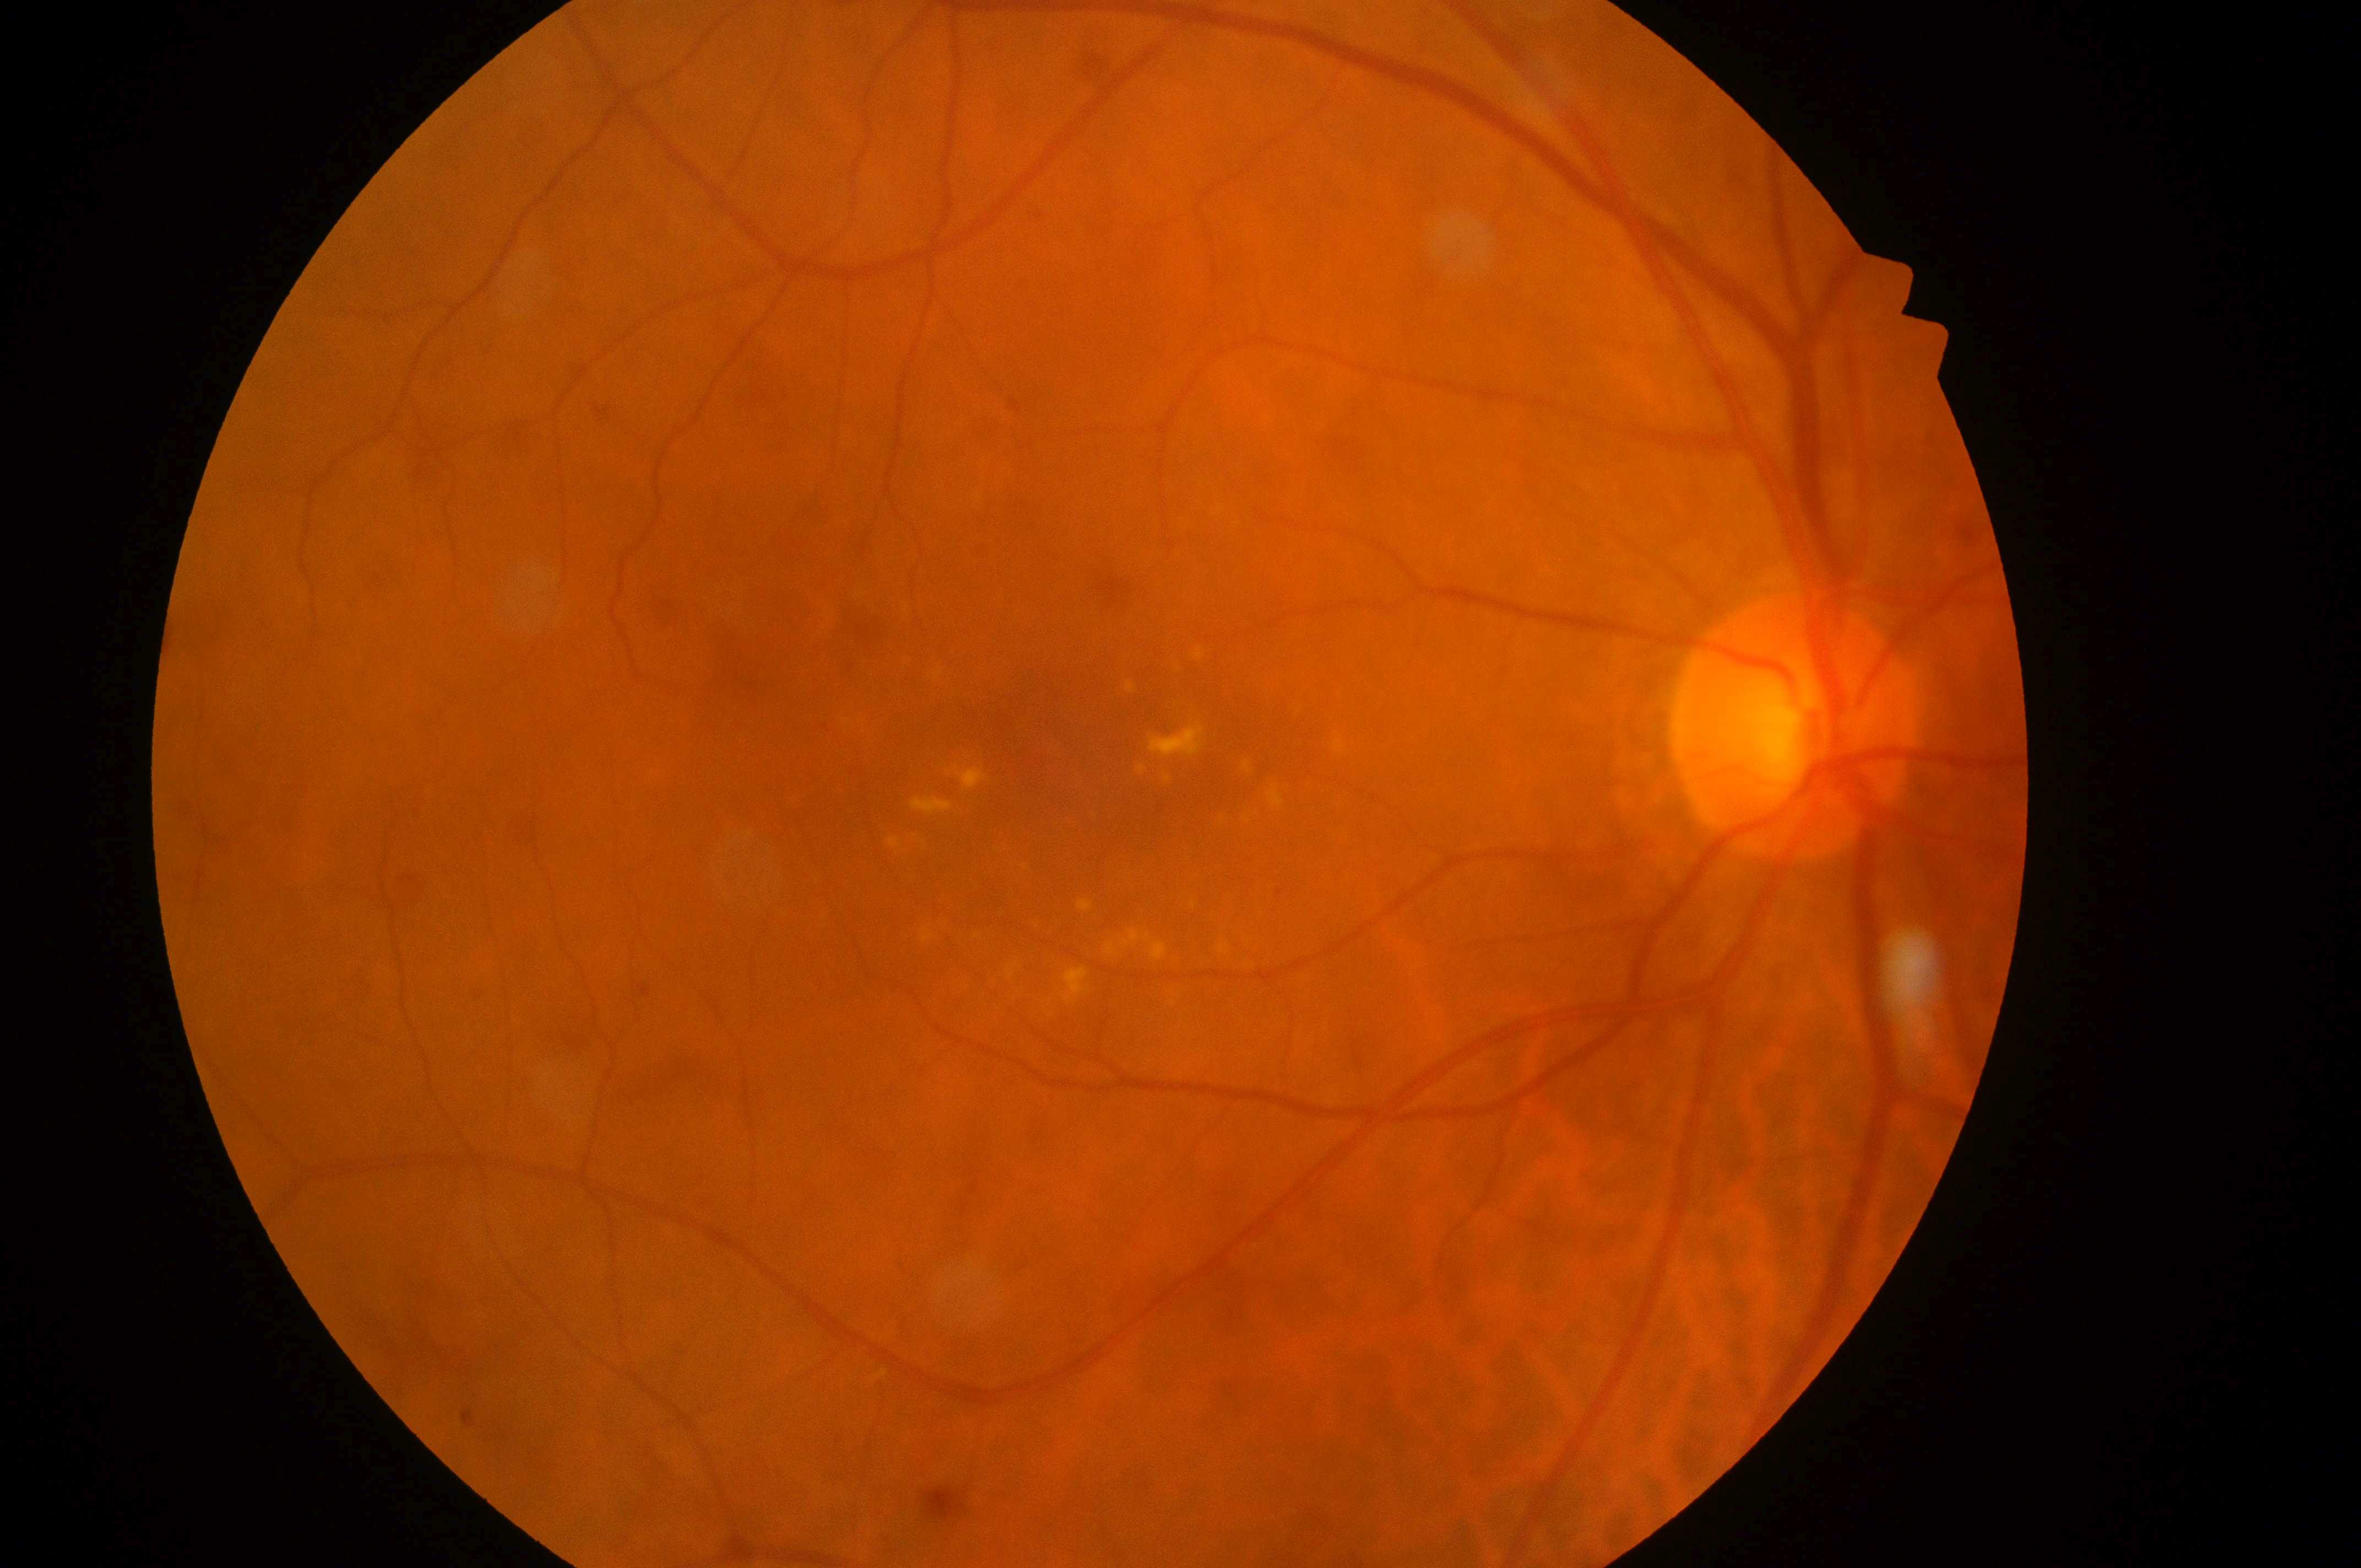 eye = OD | DR stage = grade 2 (moderate NPDR) | the optic disc = [1788, 734] | DR class = non-proliferative diabetic retinopathy | the fovea = [1101, 783] | DME grade = 2 (high risk).